Posterior pole field covering the optic disc and macula. Fundus photo — 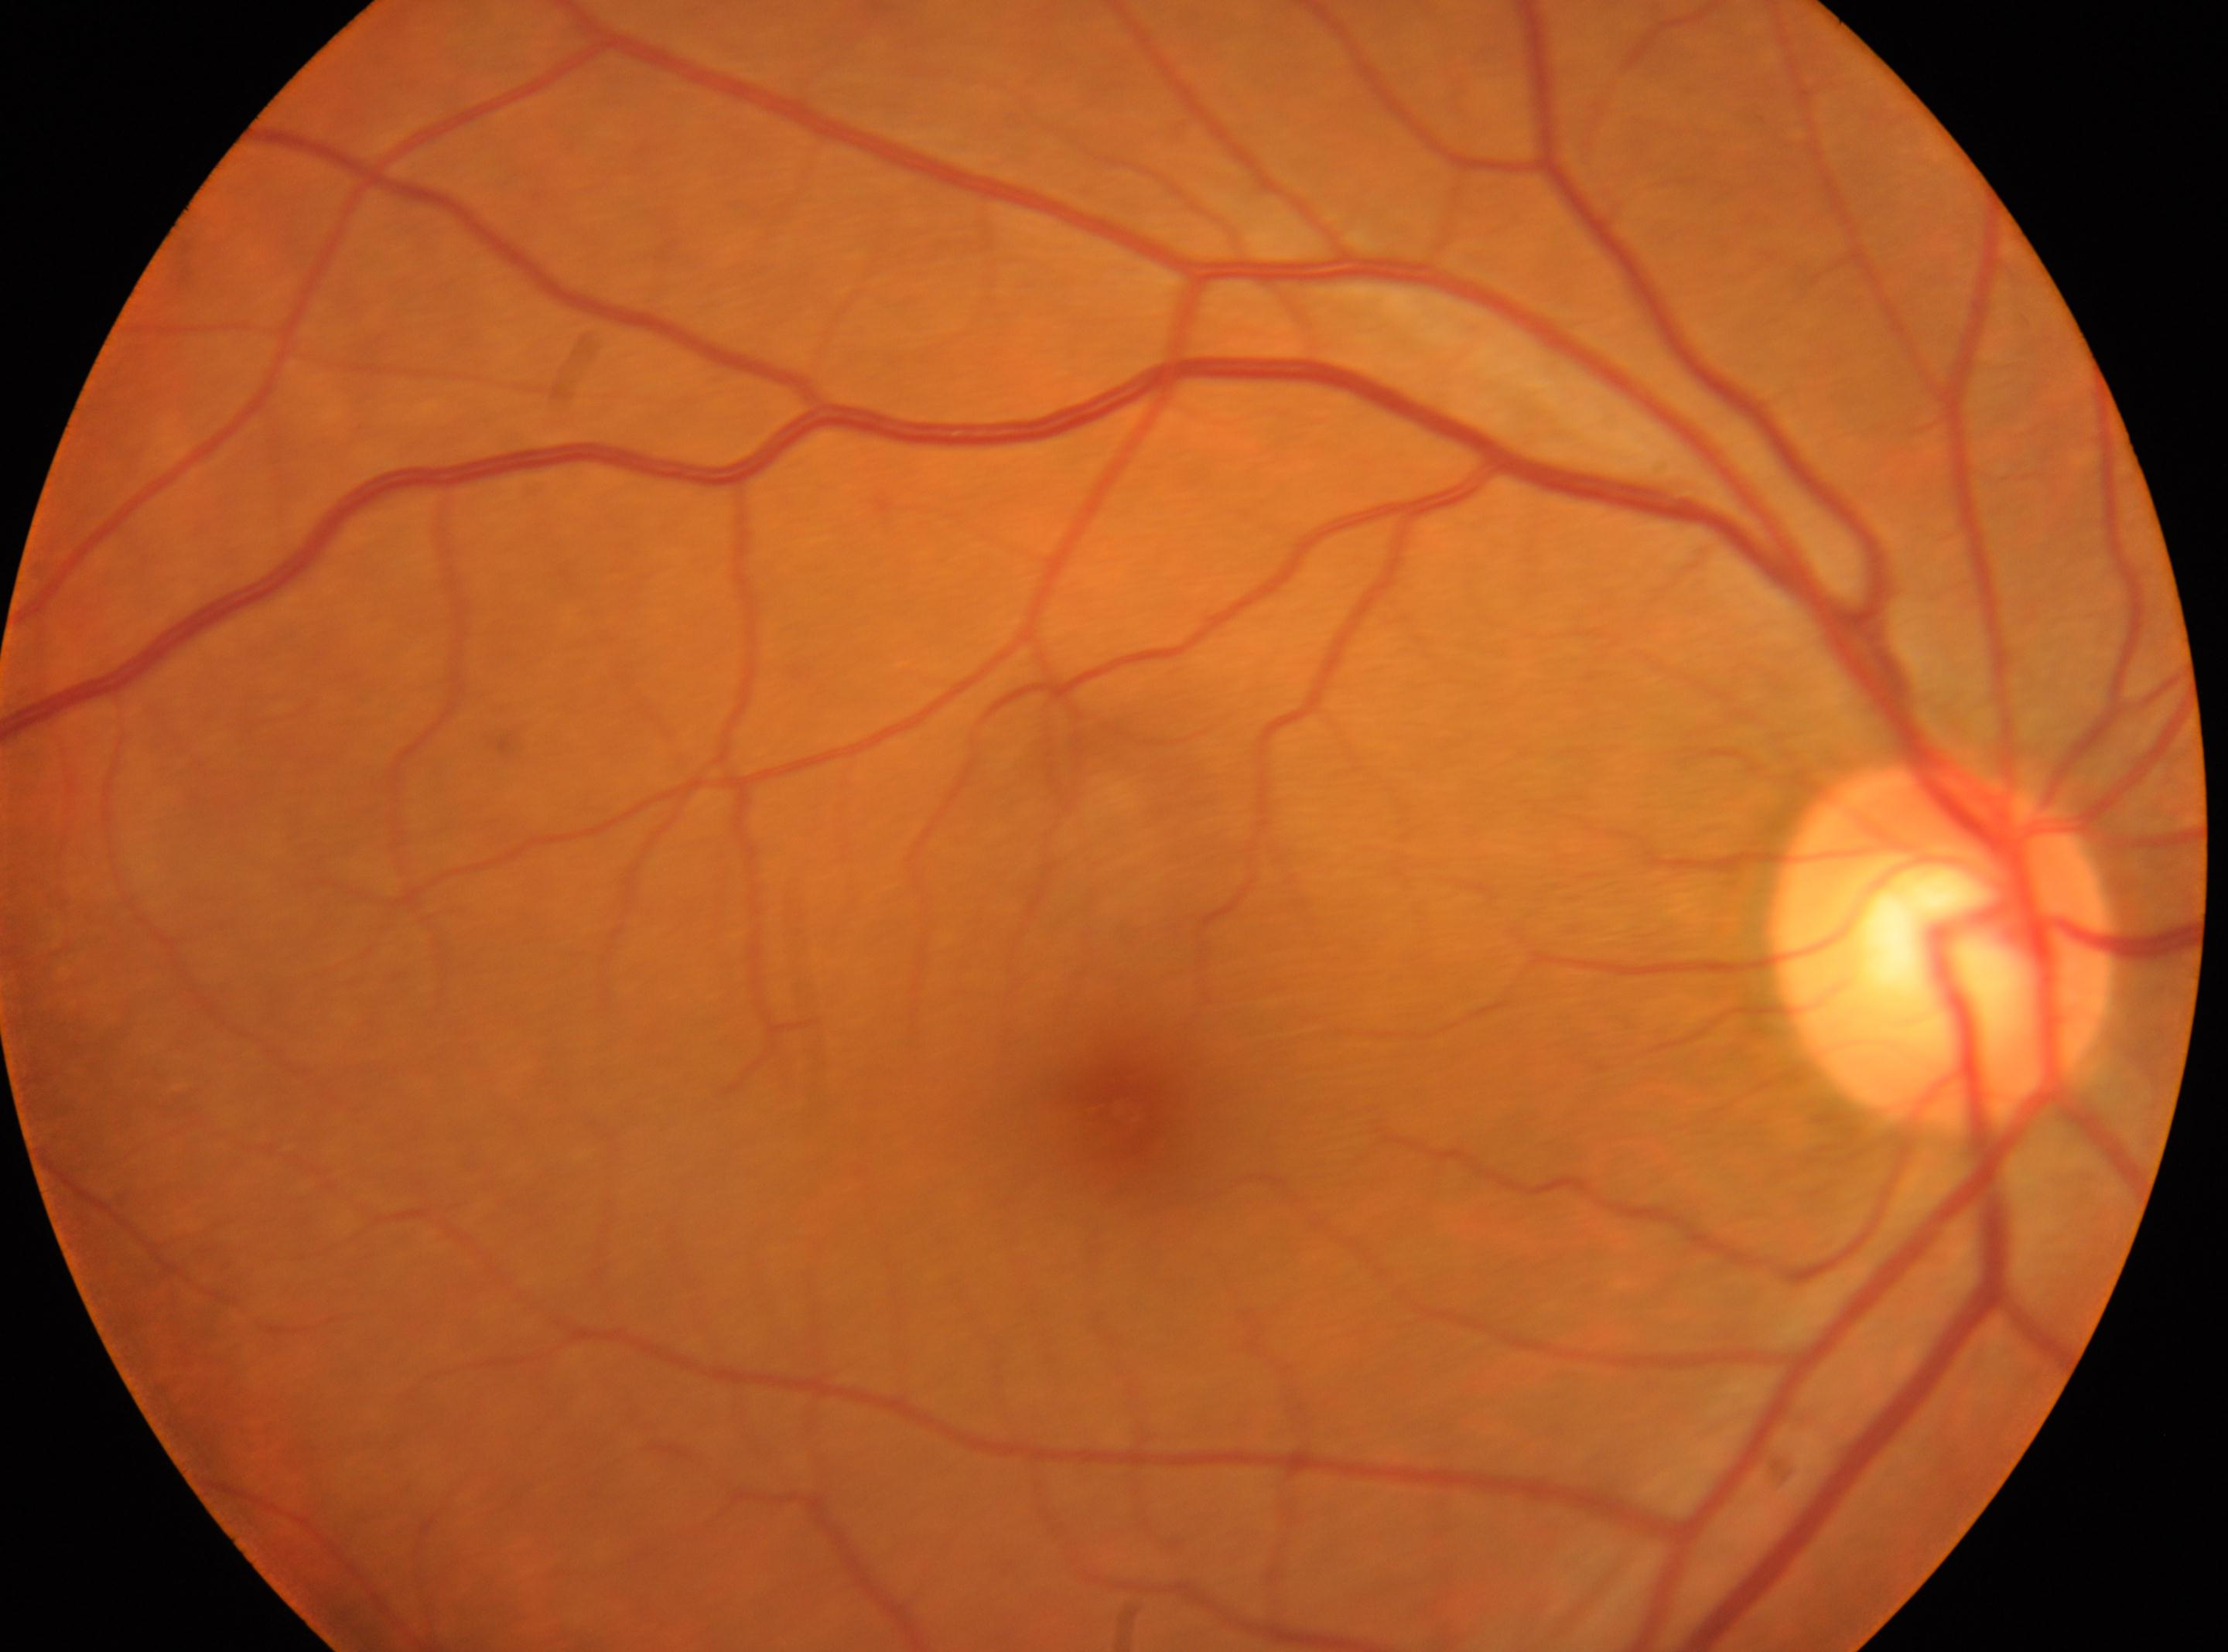

Fovea: (x=1123, y=1112). Optic disc center: (x=1941, y=944). Eye: oculus dexter. No diabetic retinal disease findings. Retinopathy is no apparent retinopathy (grade 0).